Captured on a Topcon TRC retinal camera; color fundus photograph centered on the optic disc: 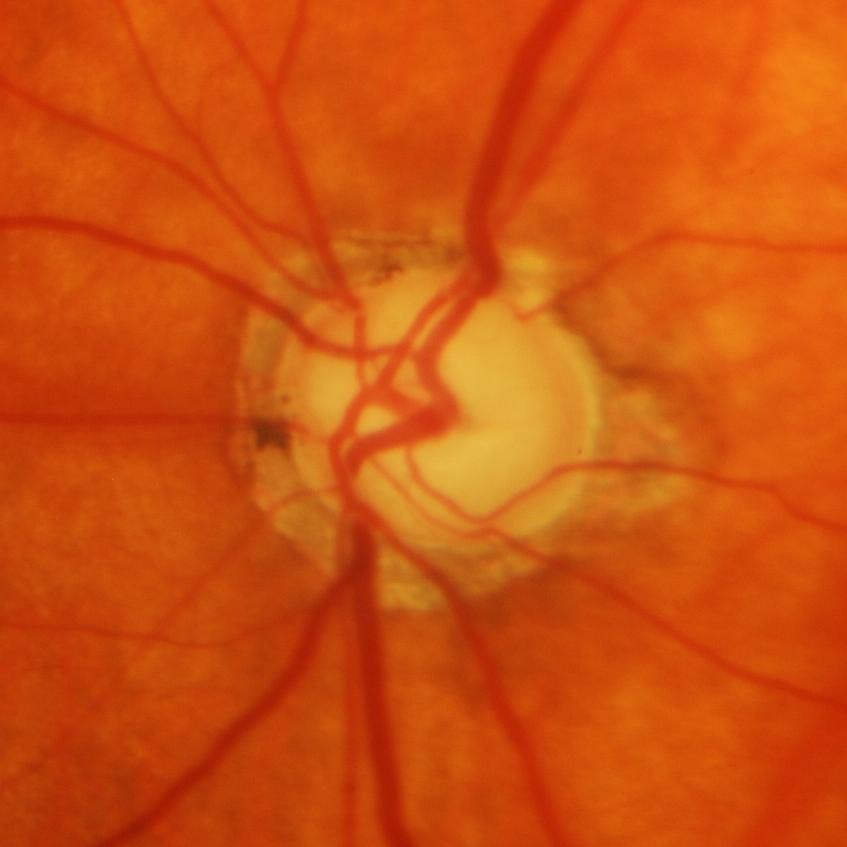
Glaucomatous optic neuropathy.